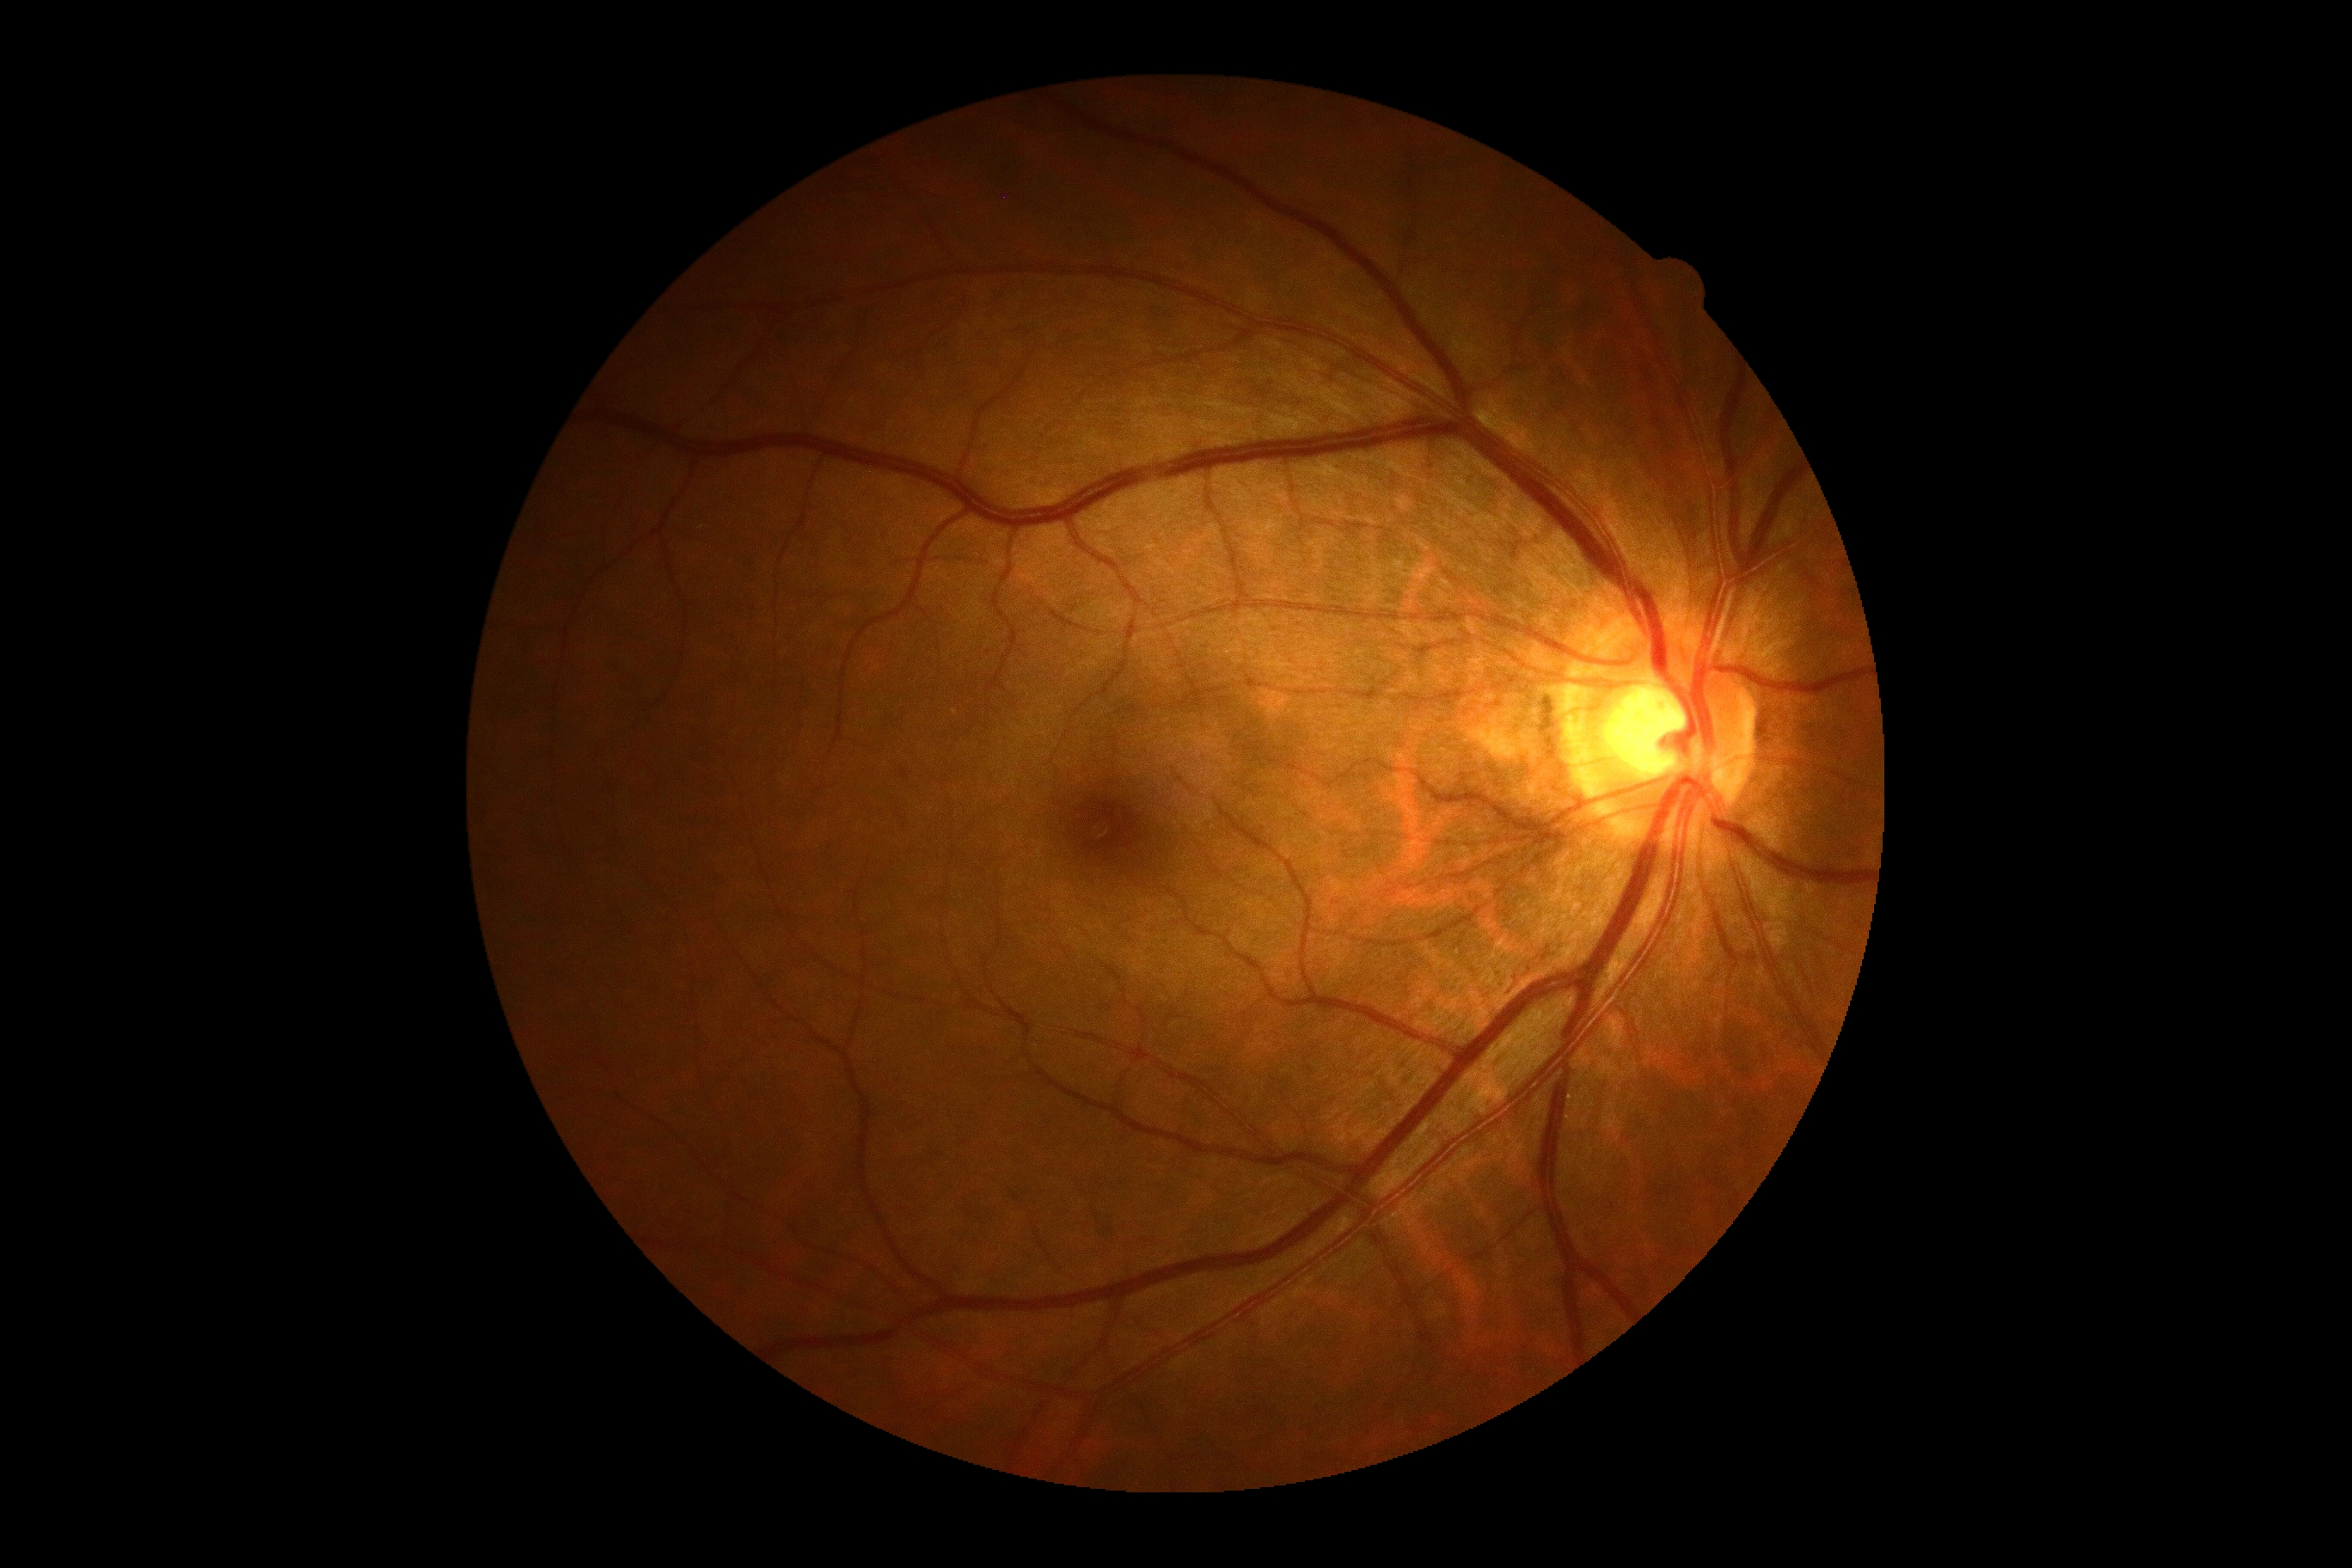
Retinopathy is no apparent retinopathy (grade 0).